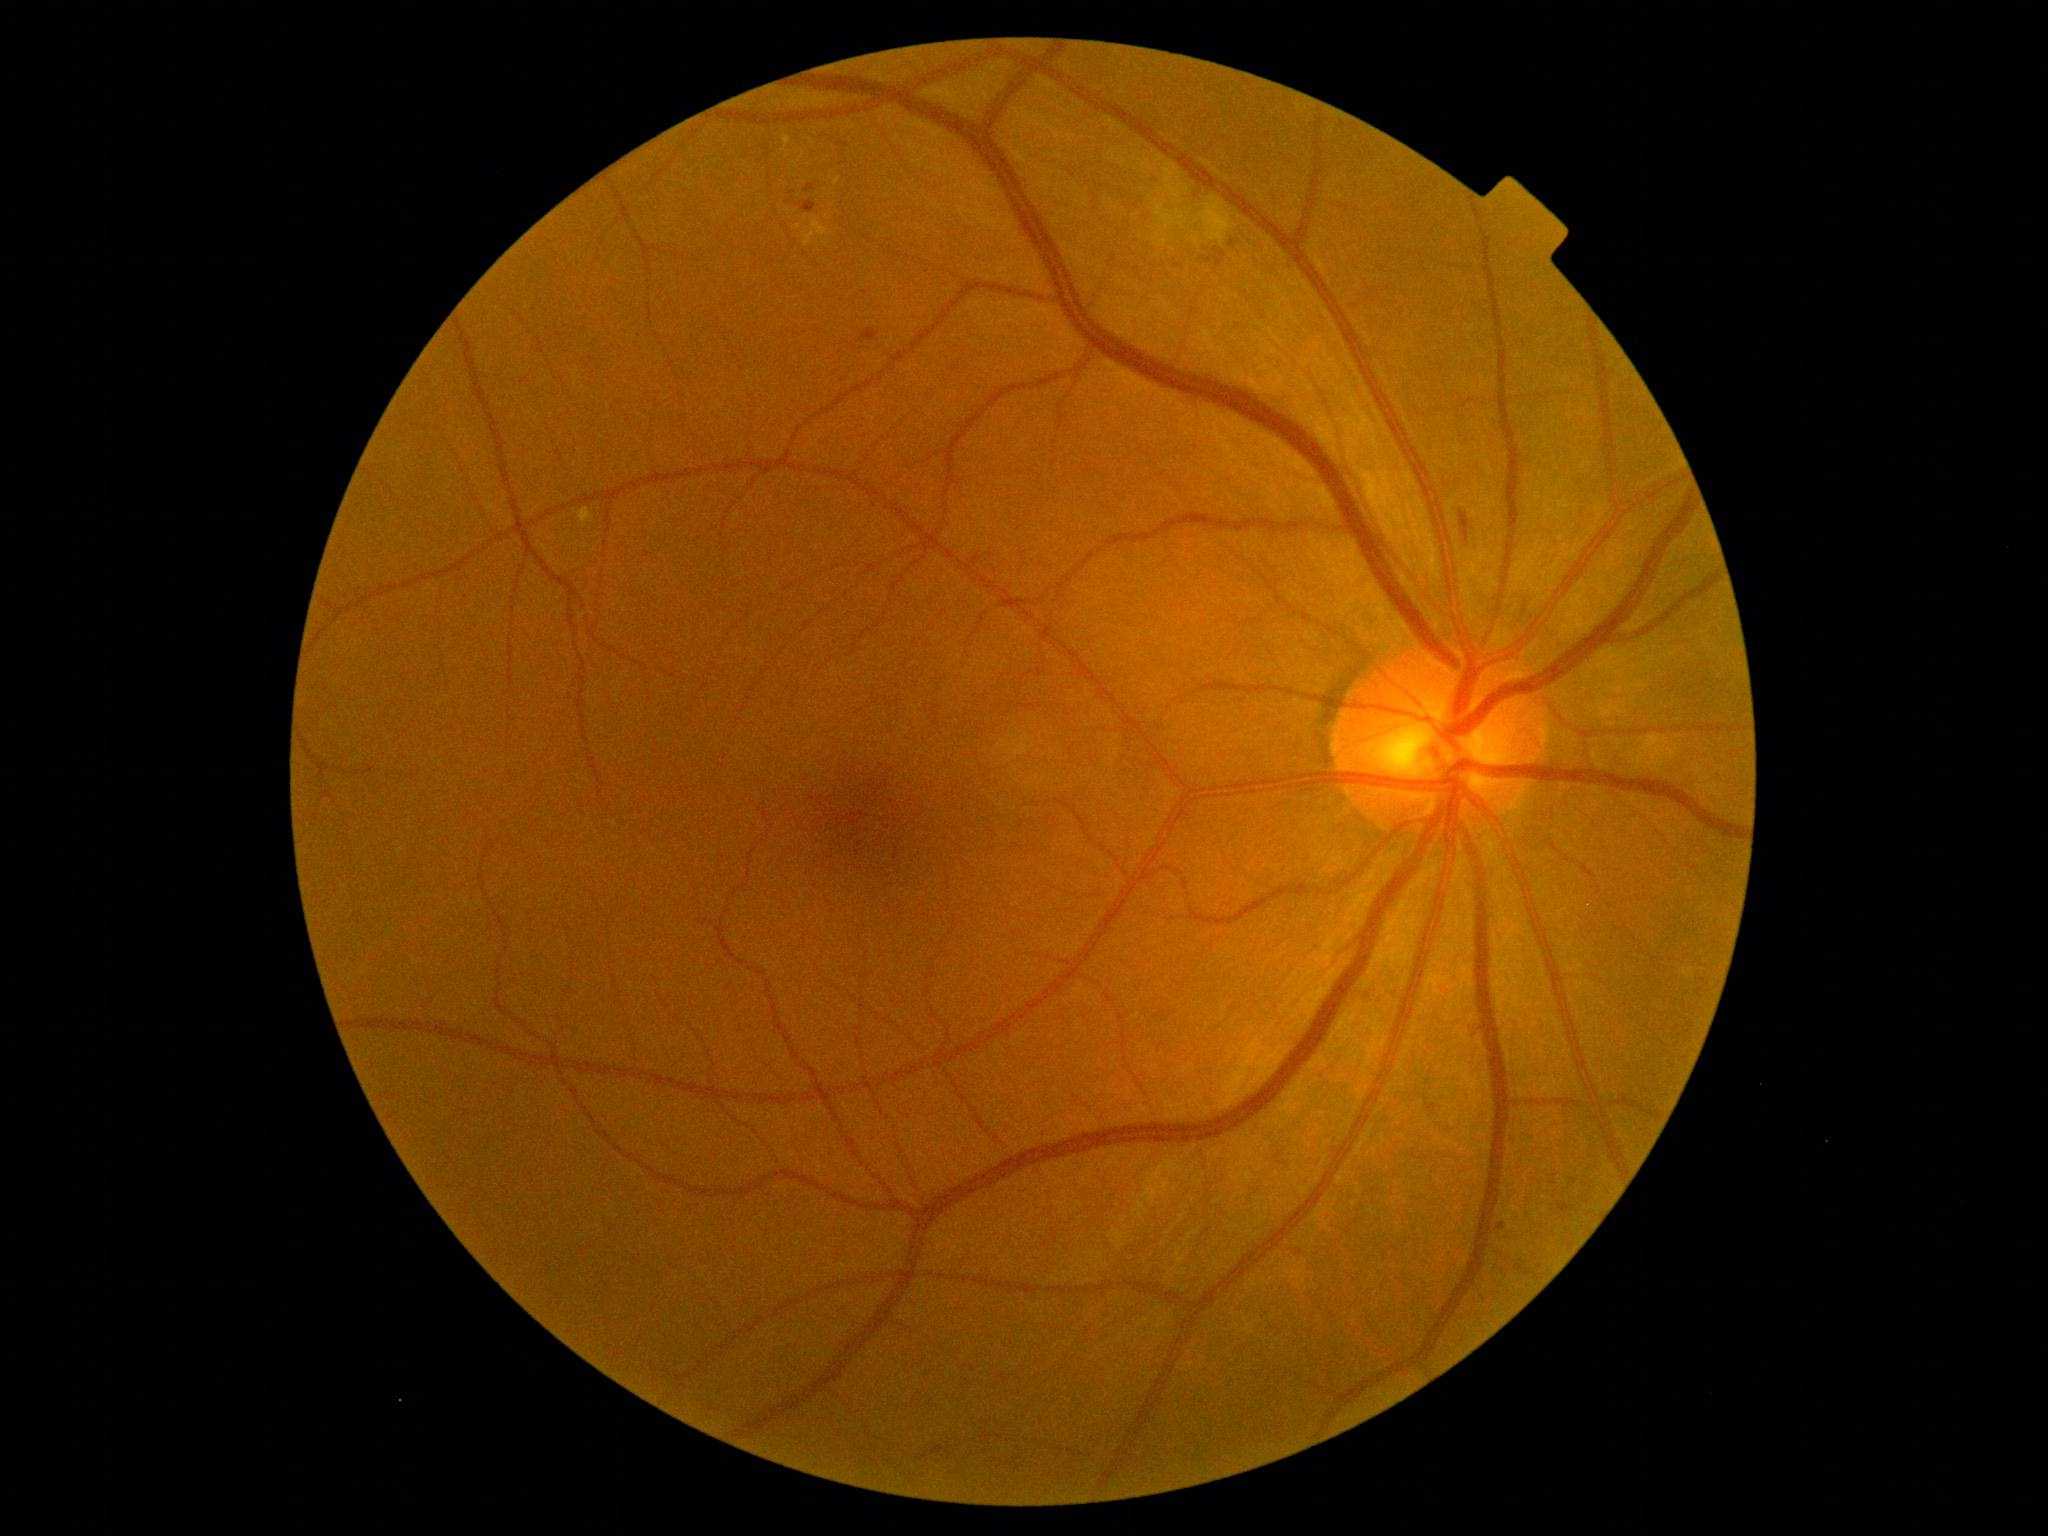

Diabetic retinopathy (DR): 2.